NIDEK AFC-230. DR severity per modified Davis staging.
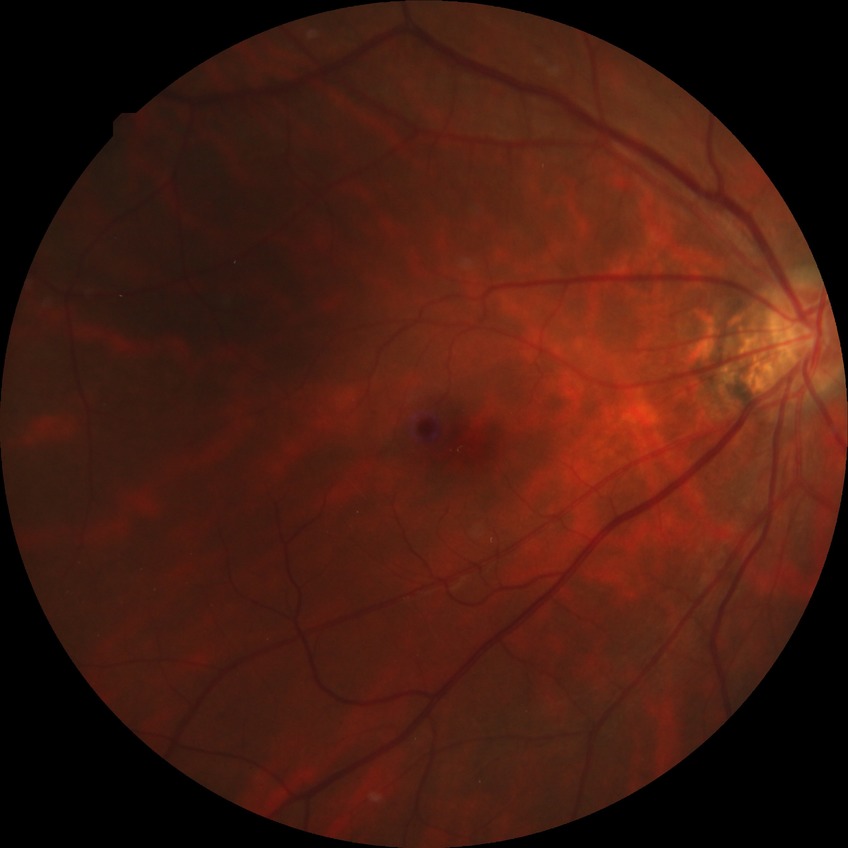

diabetic retinopathy (DR): no diabetic retinopathy (NDR).